848x848; posterior pole color fundus photograph — 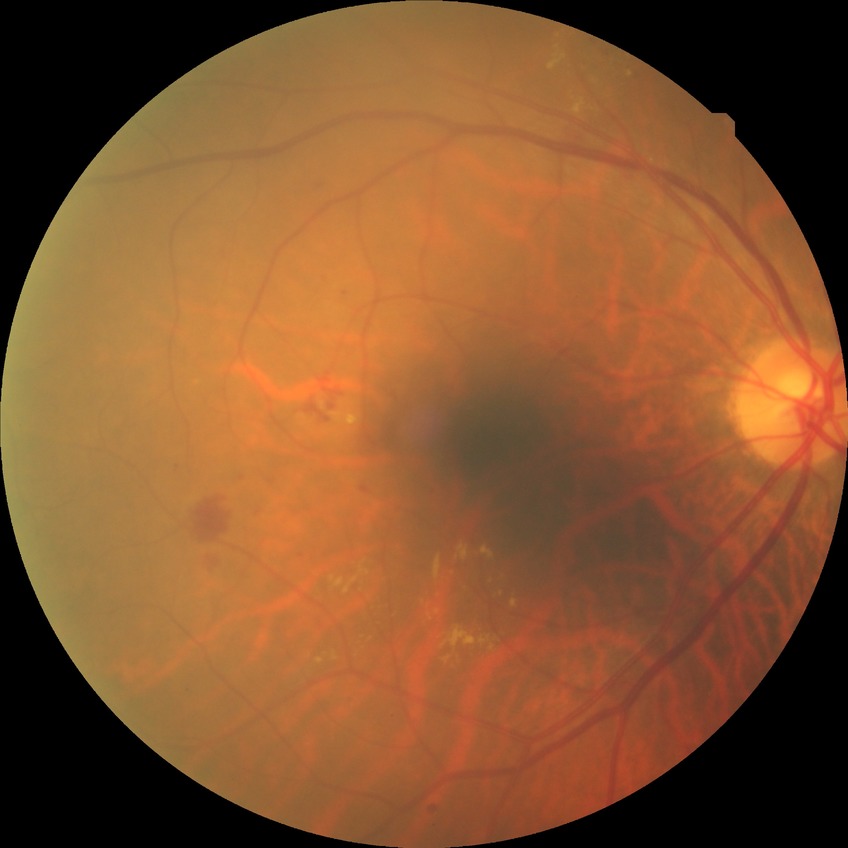

DR: SDR.